Nonmydriatic. Modified Davis classification.
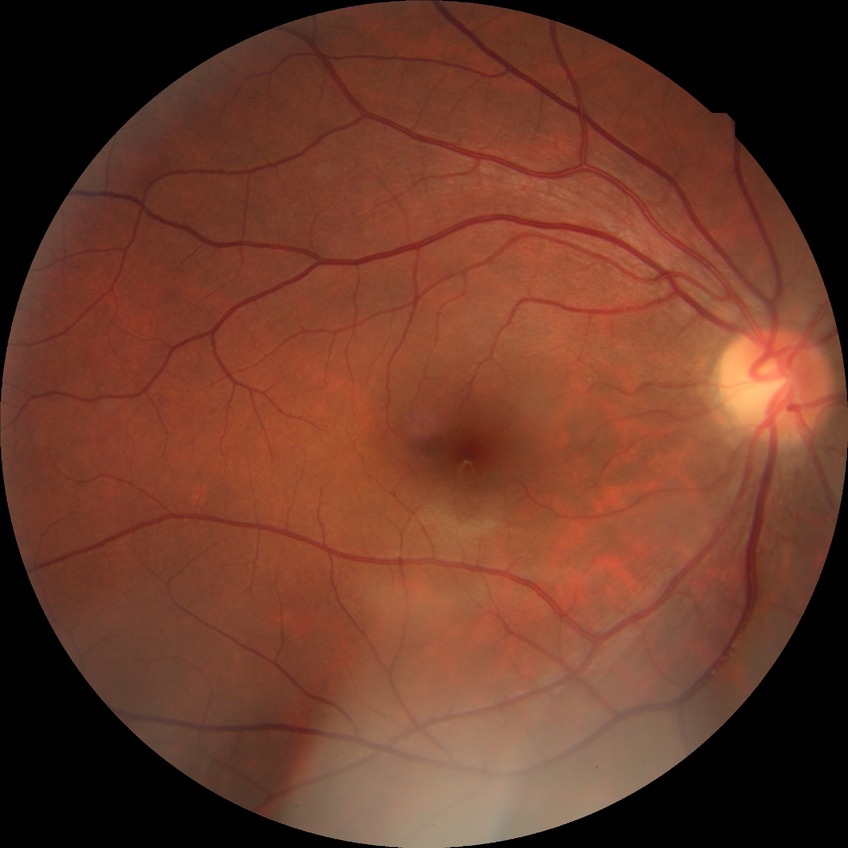
Diabetic retinopathy severity: no diabetic retinopathy.